848 x 848 pixels, 45-degree field of view
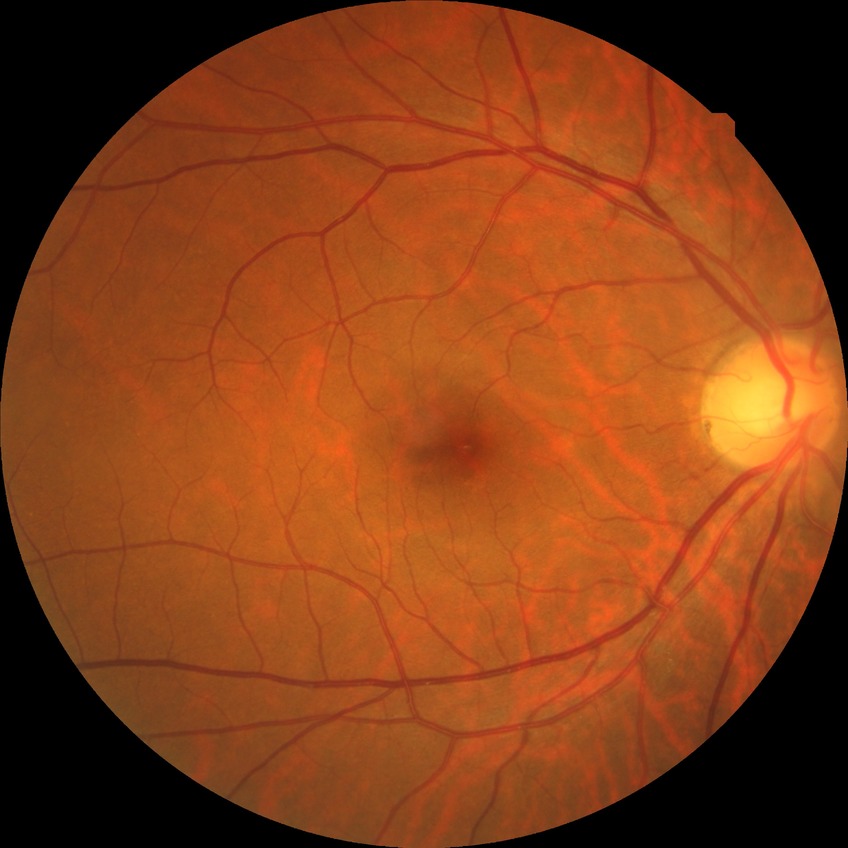

Retinopathy stage is no diabetic retinopathy.